Fundus photo · 2352 by 1568 pixels — 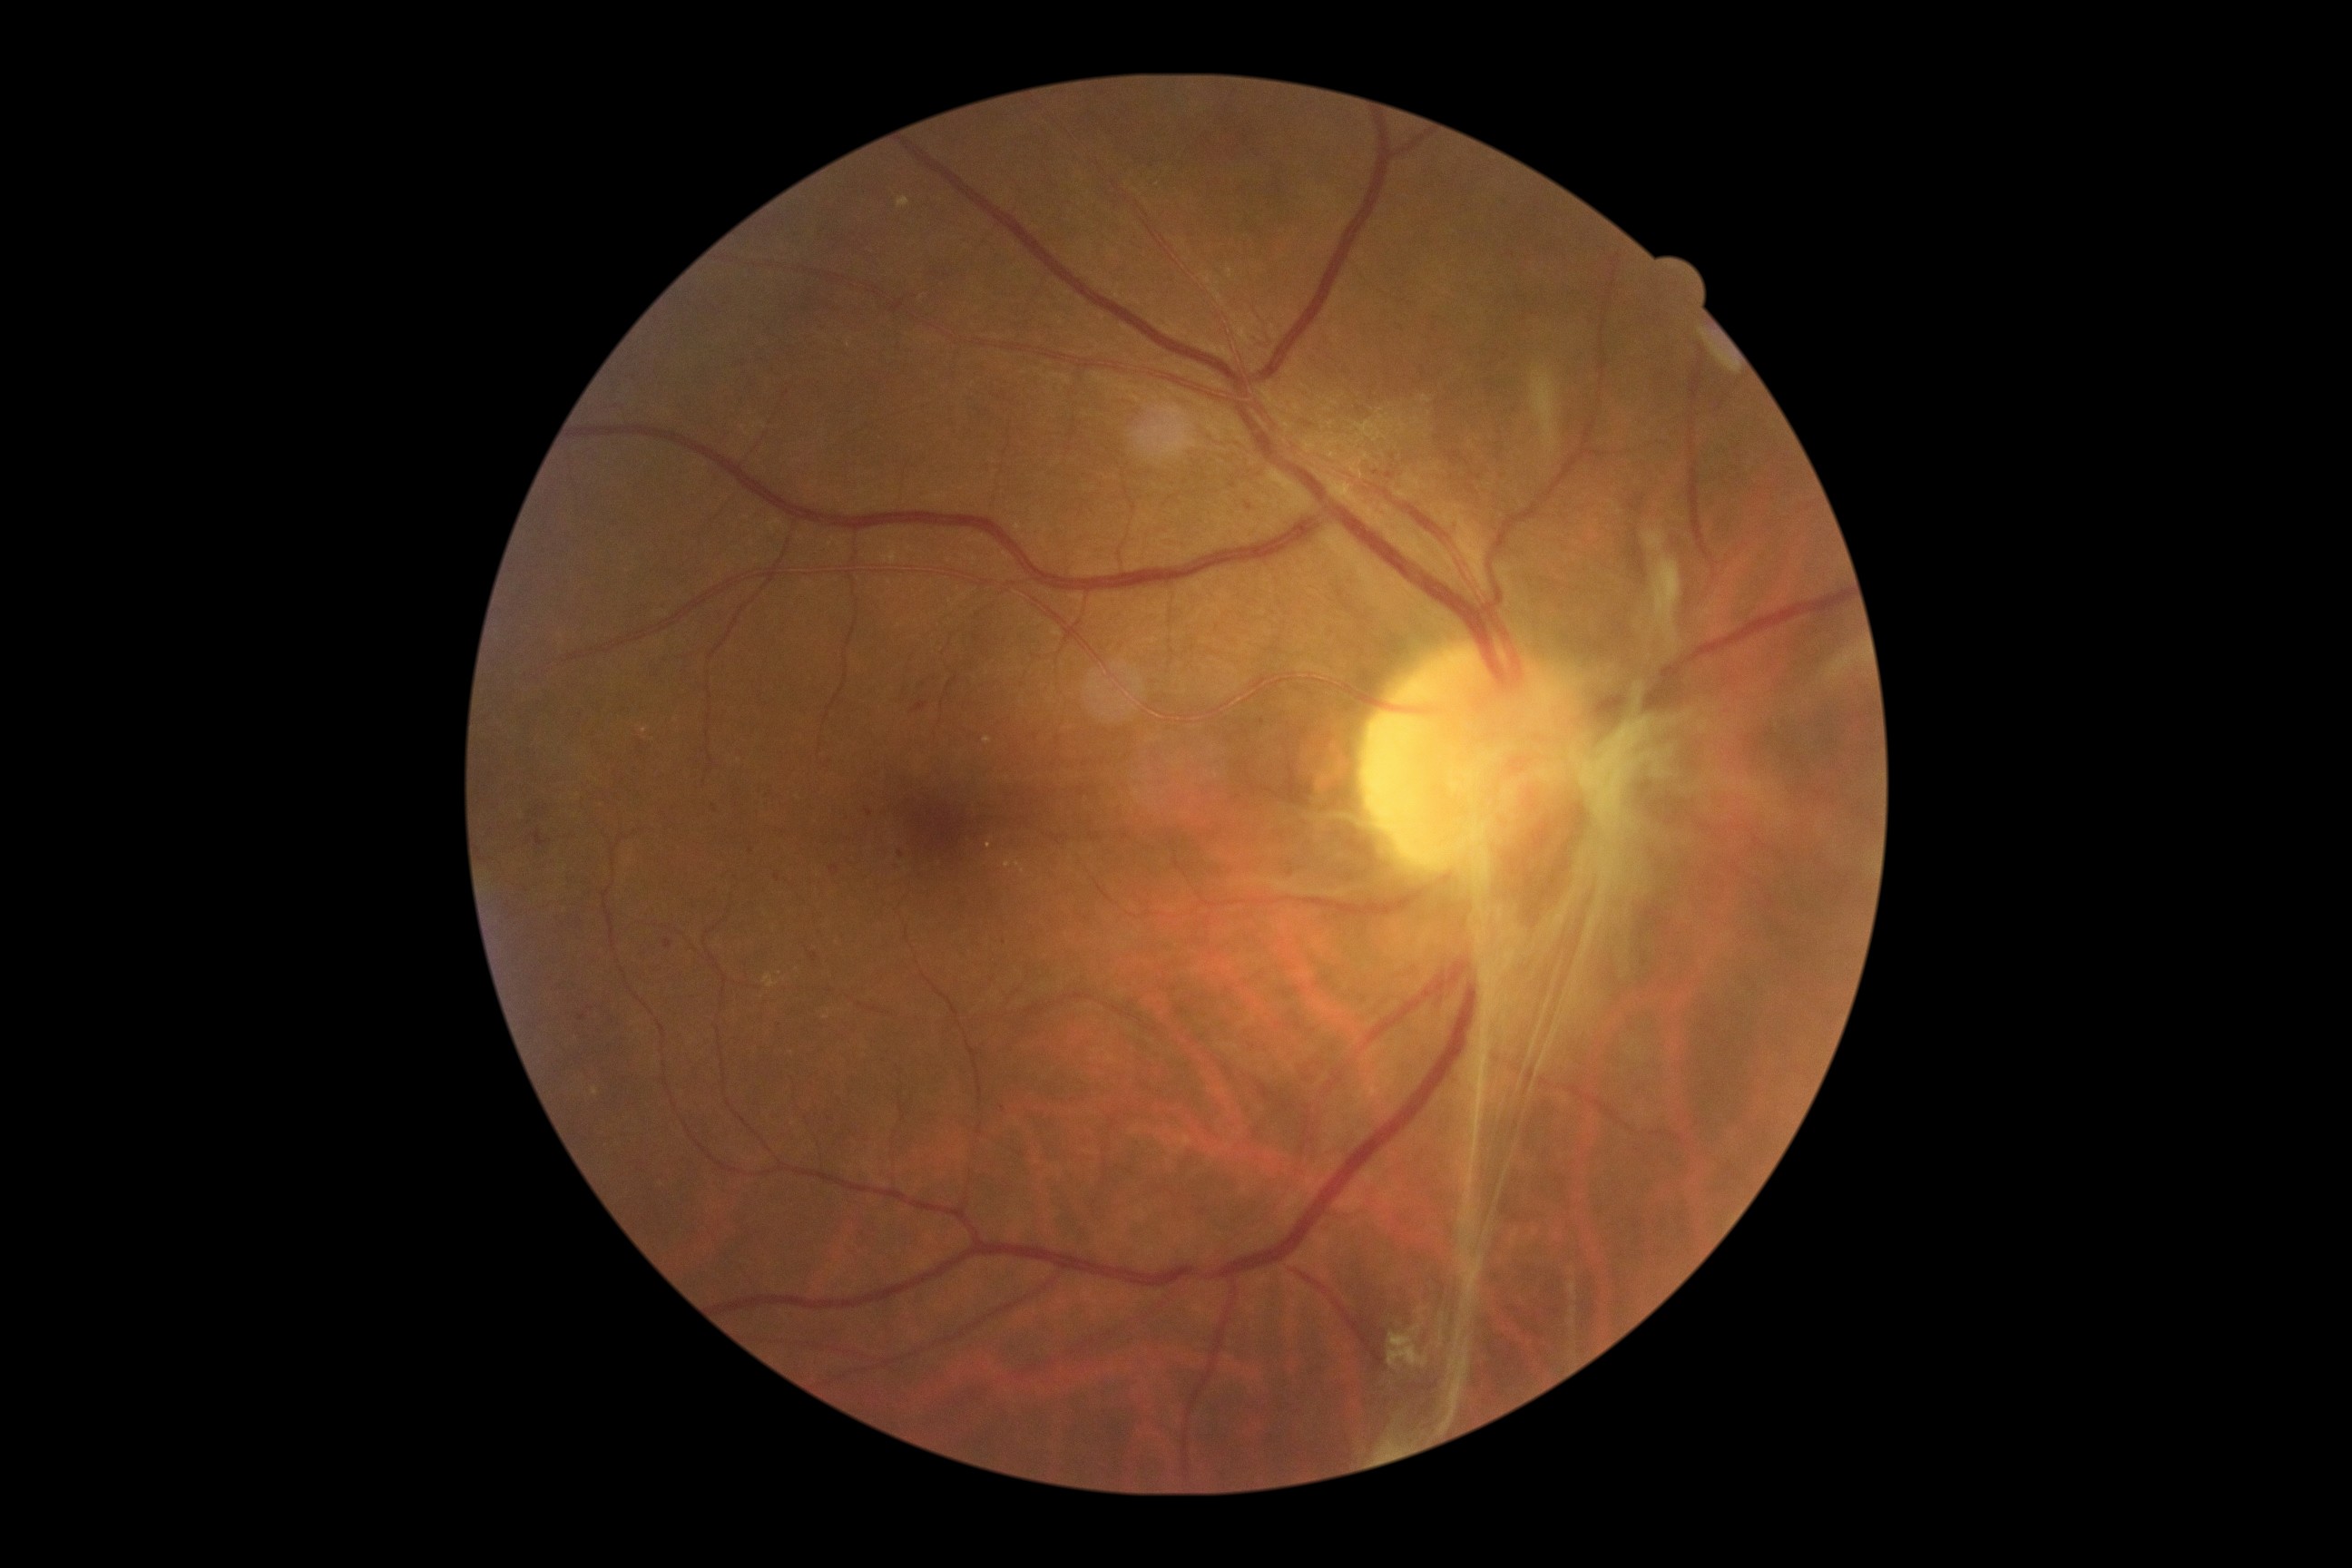

Diabetic retinopathy (DR) is PDR (grade 4).